Phoenix ICON wide-field infant fundus image.
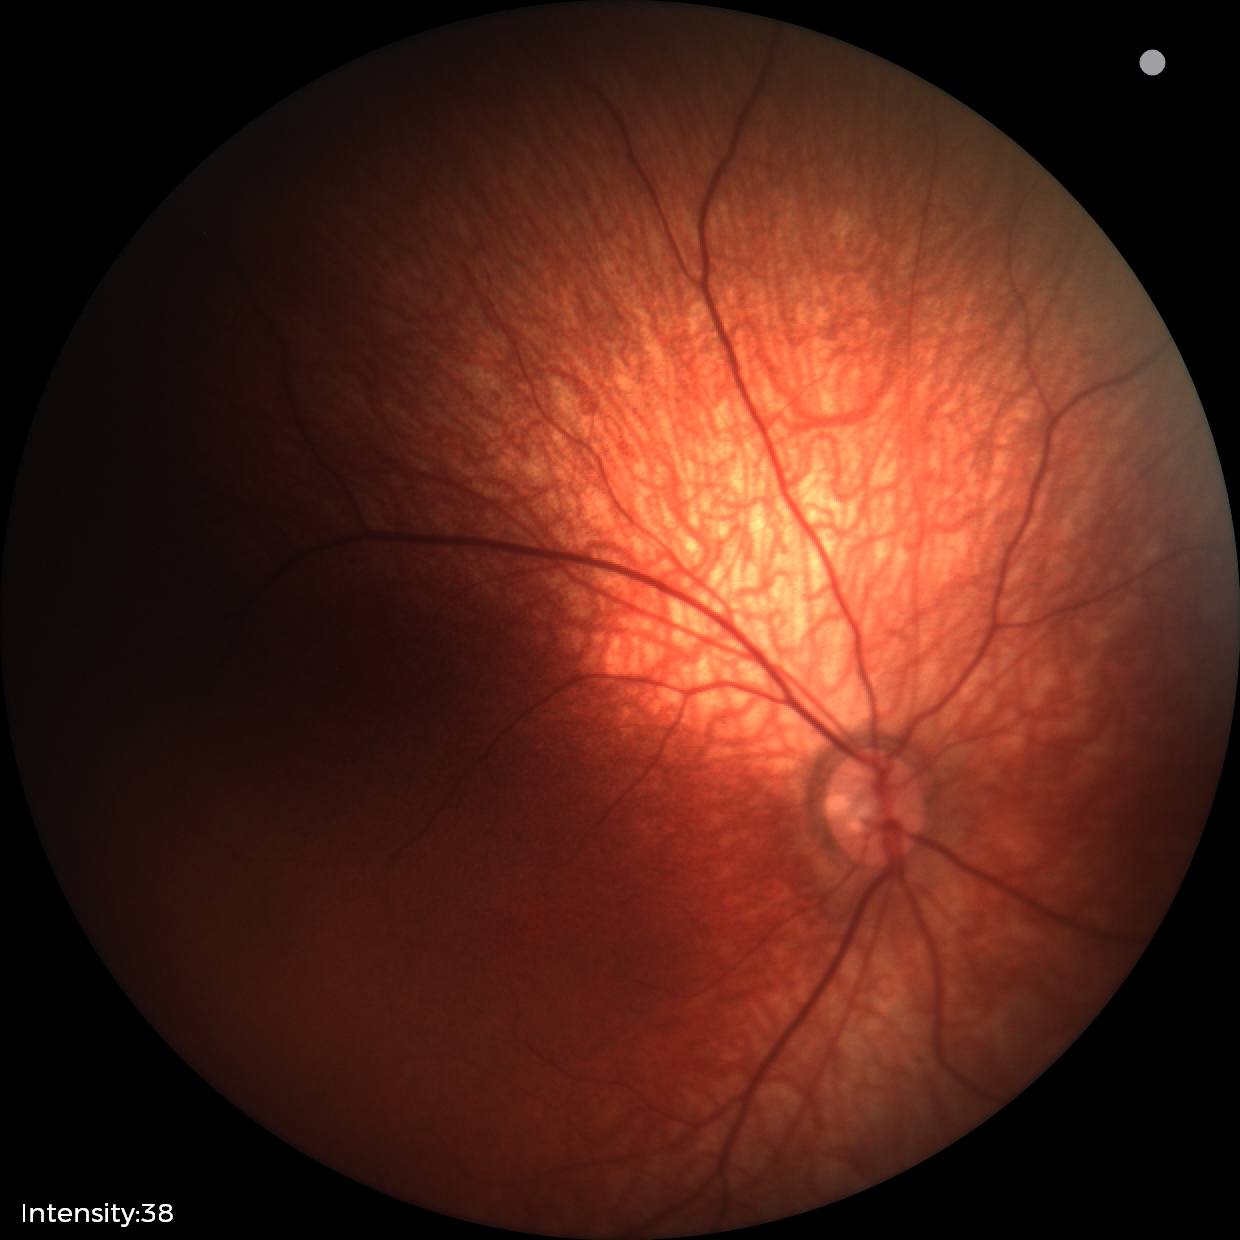

No retinal pathology identified on screening.